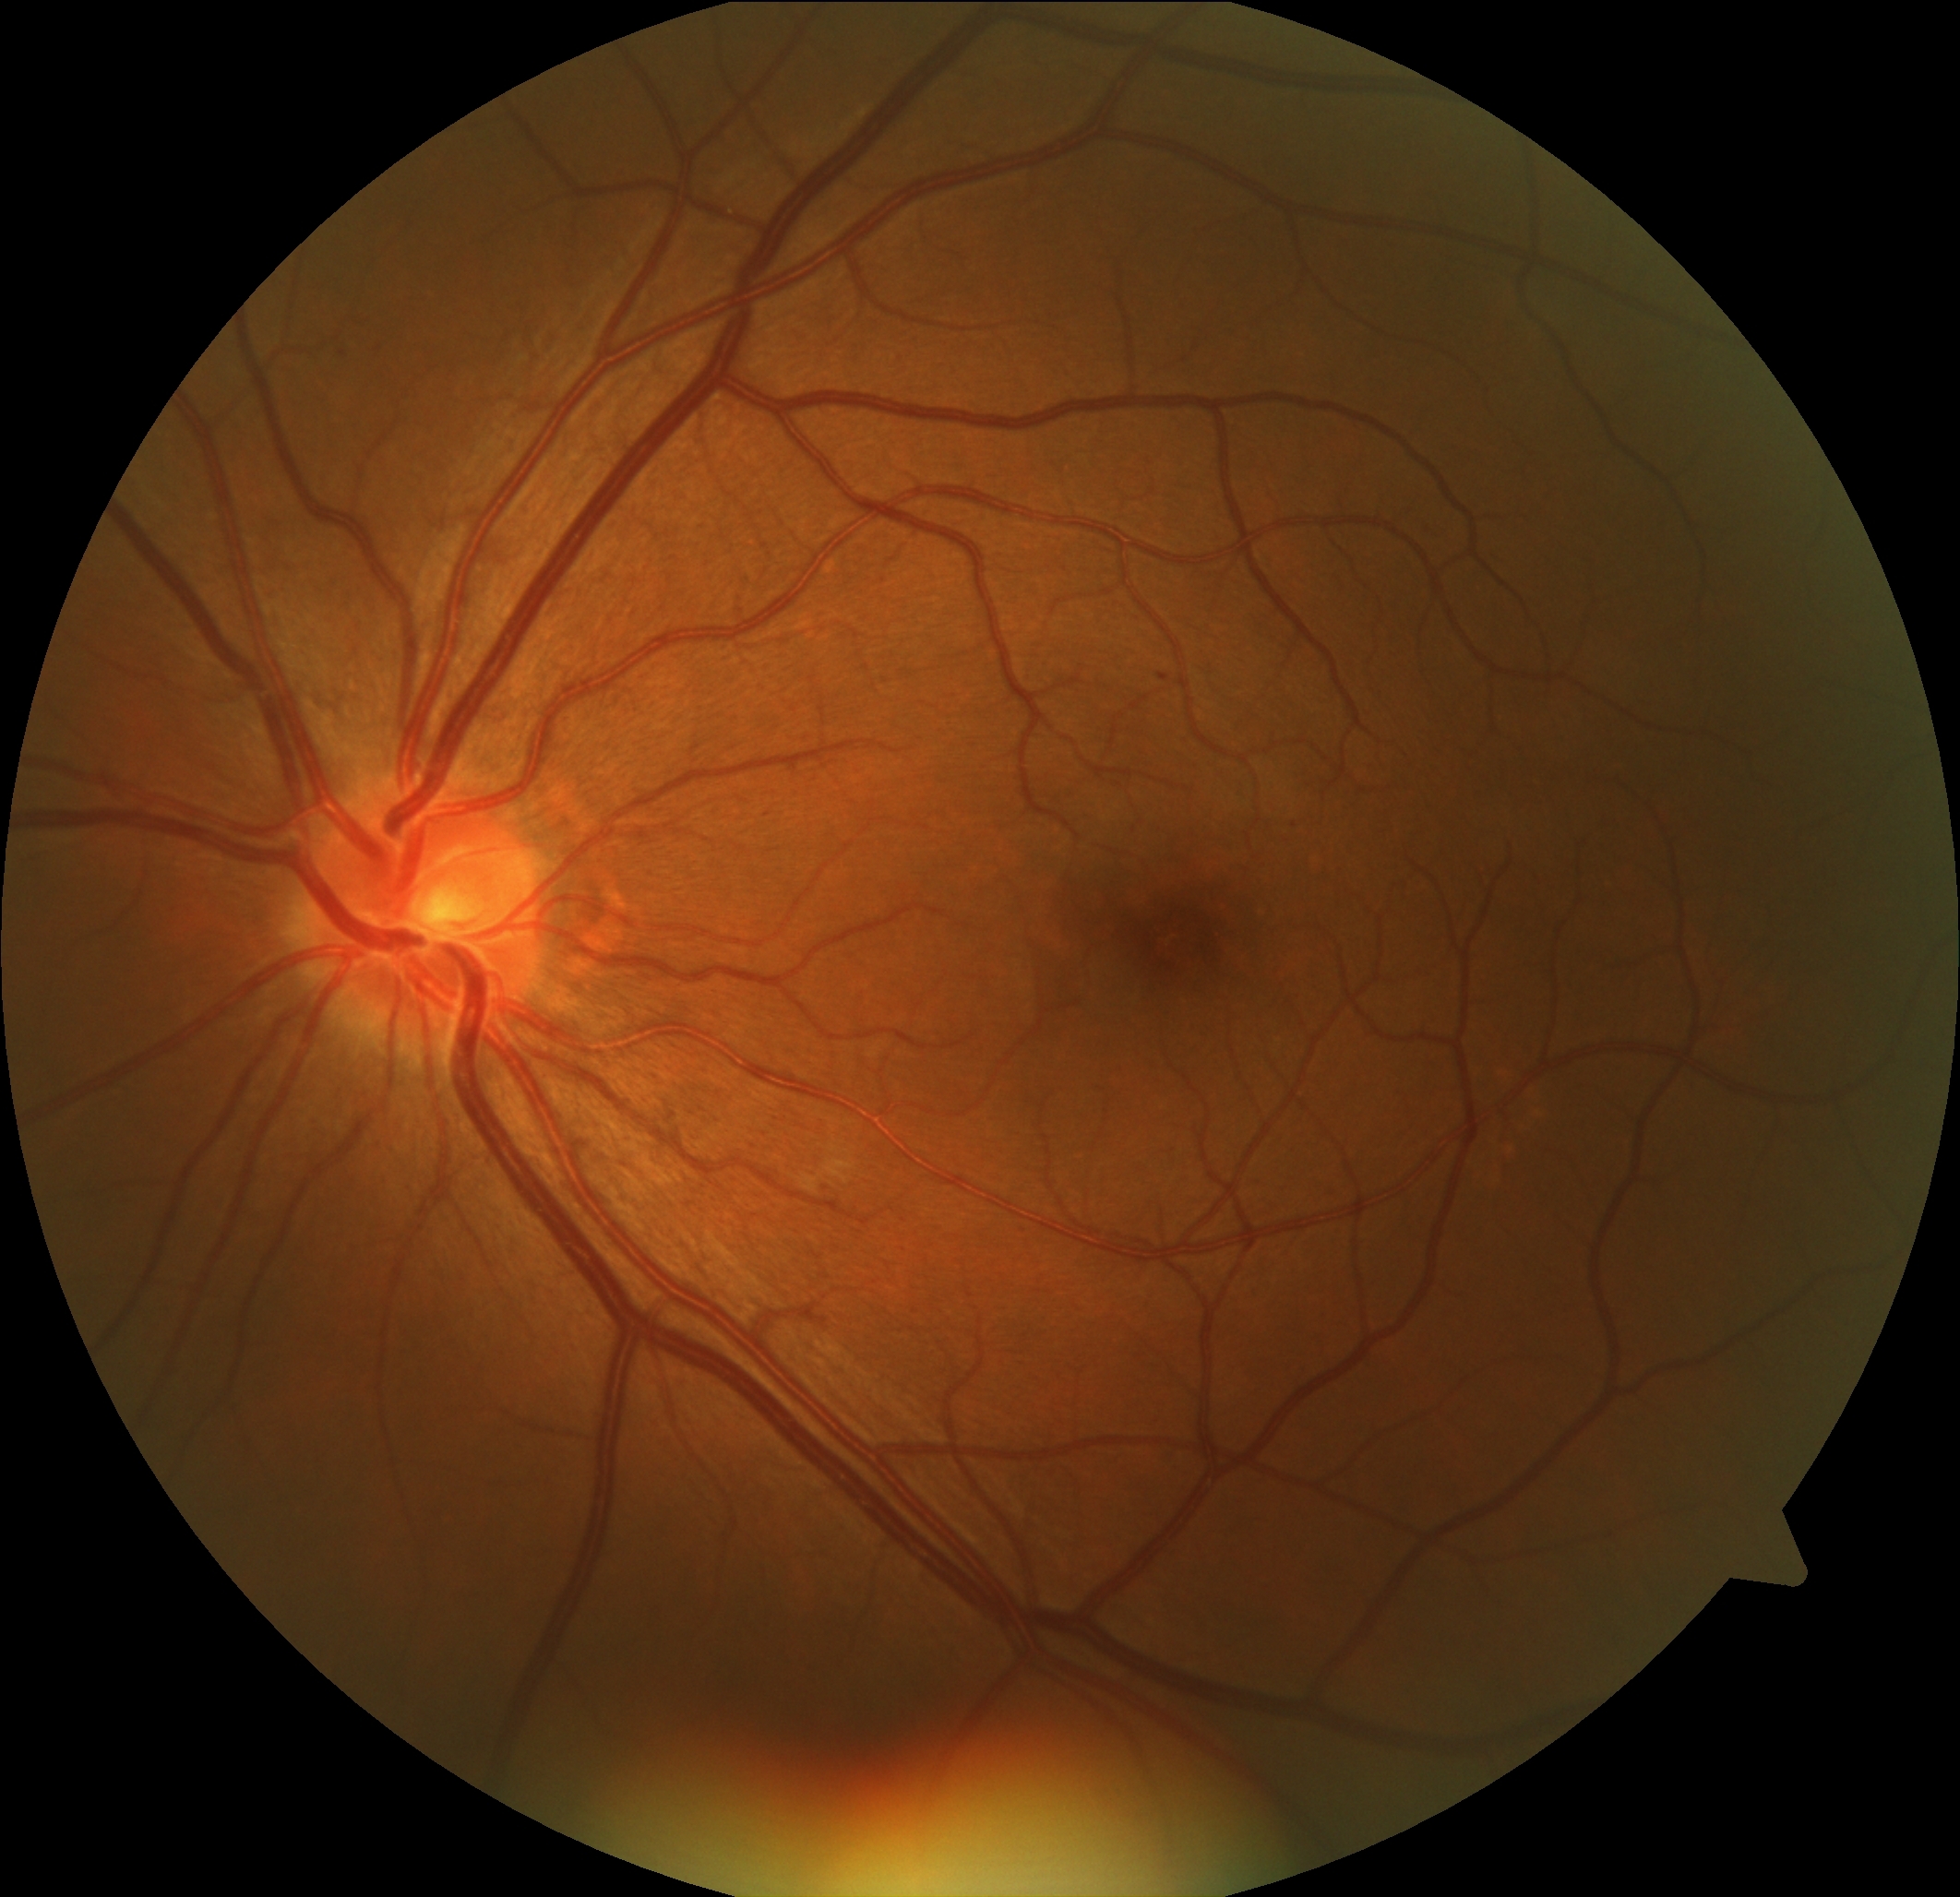
DR class@non-proliferative diabetic retinopathy; retinopathy grade@1 (mild NPDR).